Infant wide-field fundus photograph:
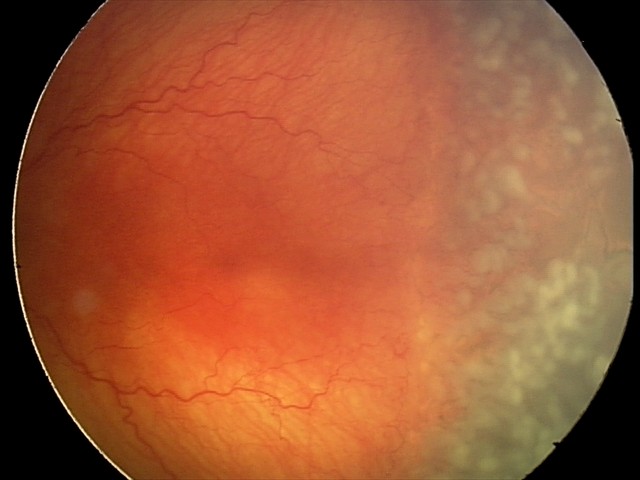
Plus disease: present, assessment: aggressive retinopathy of prematurity (A-ROP).